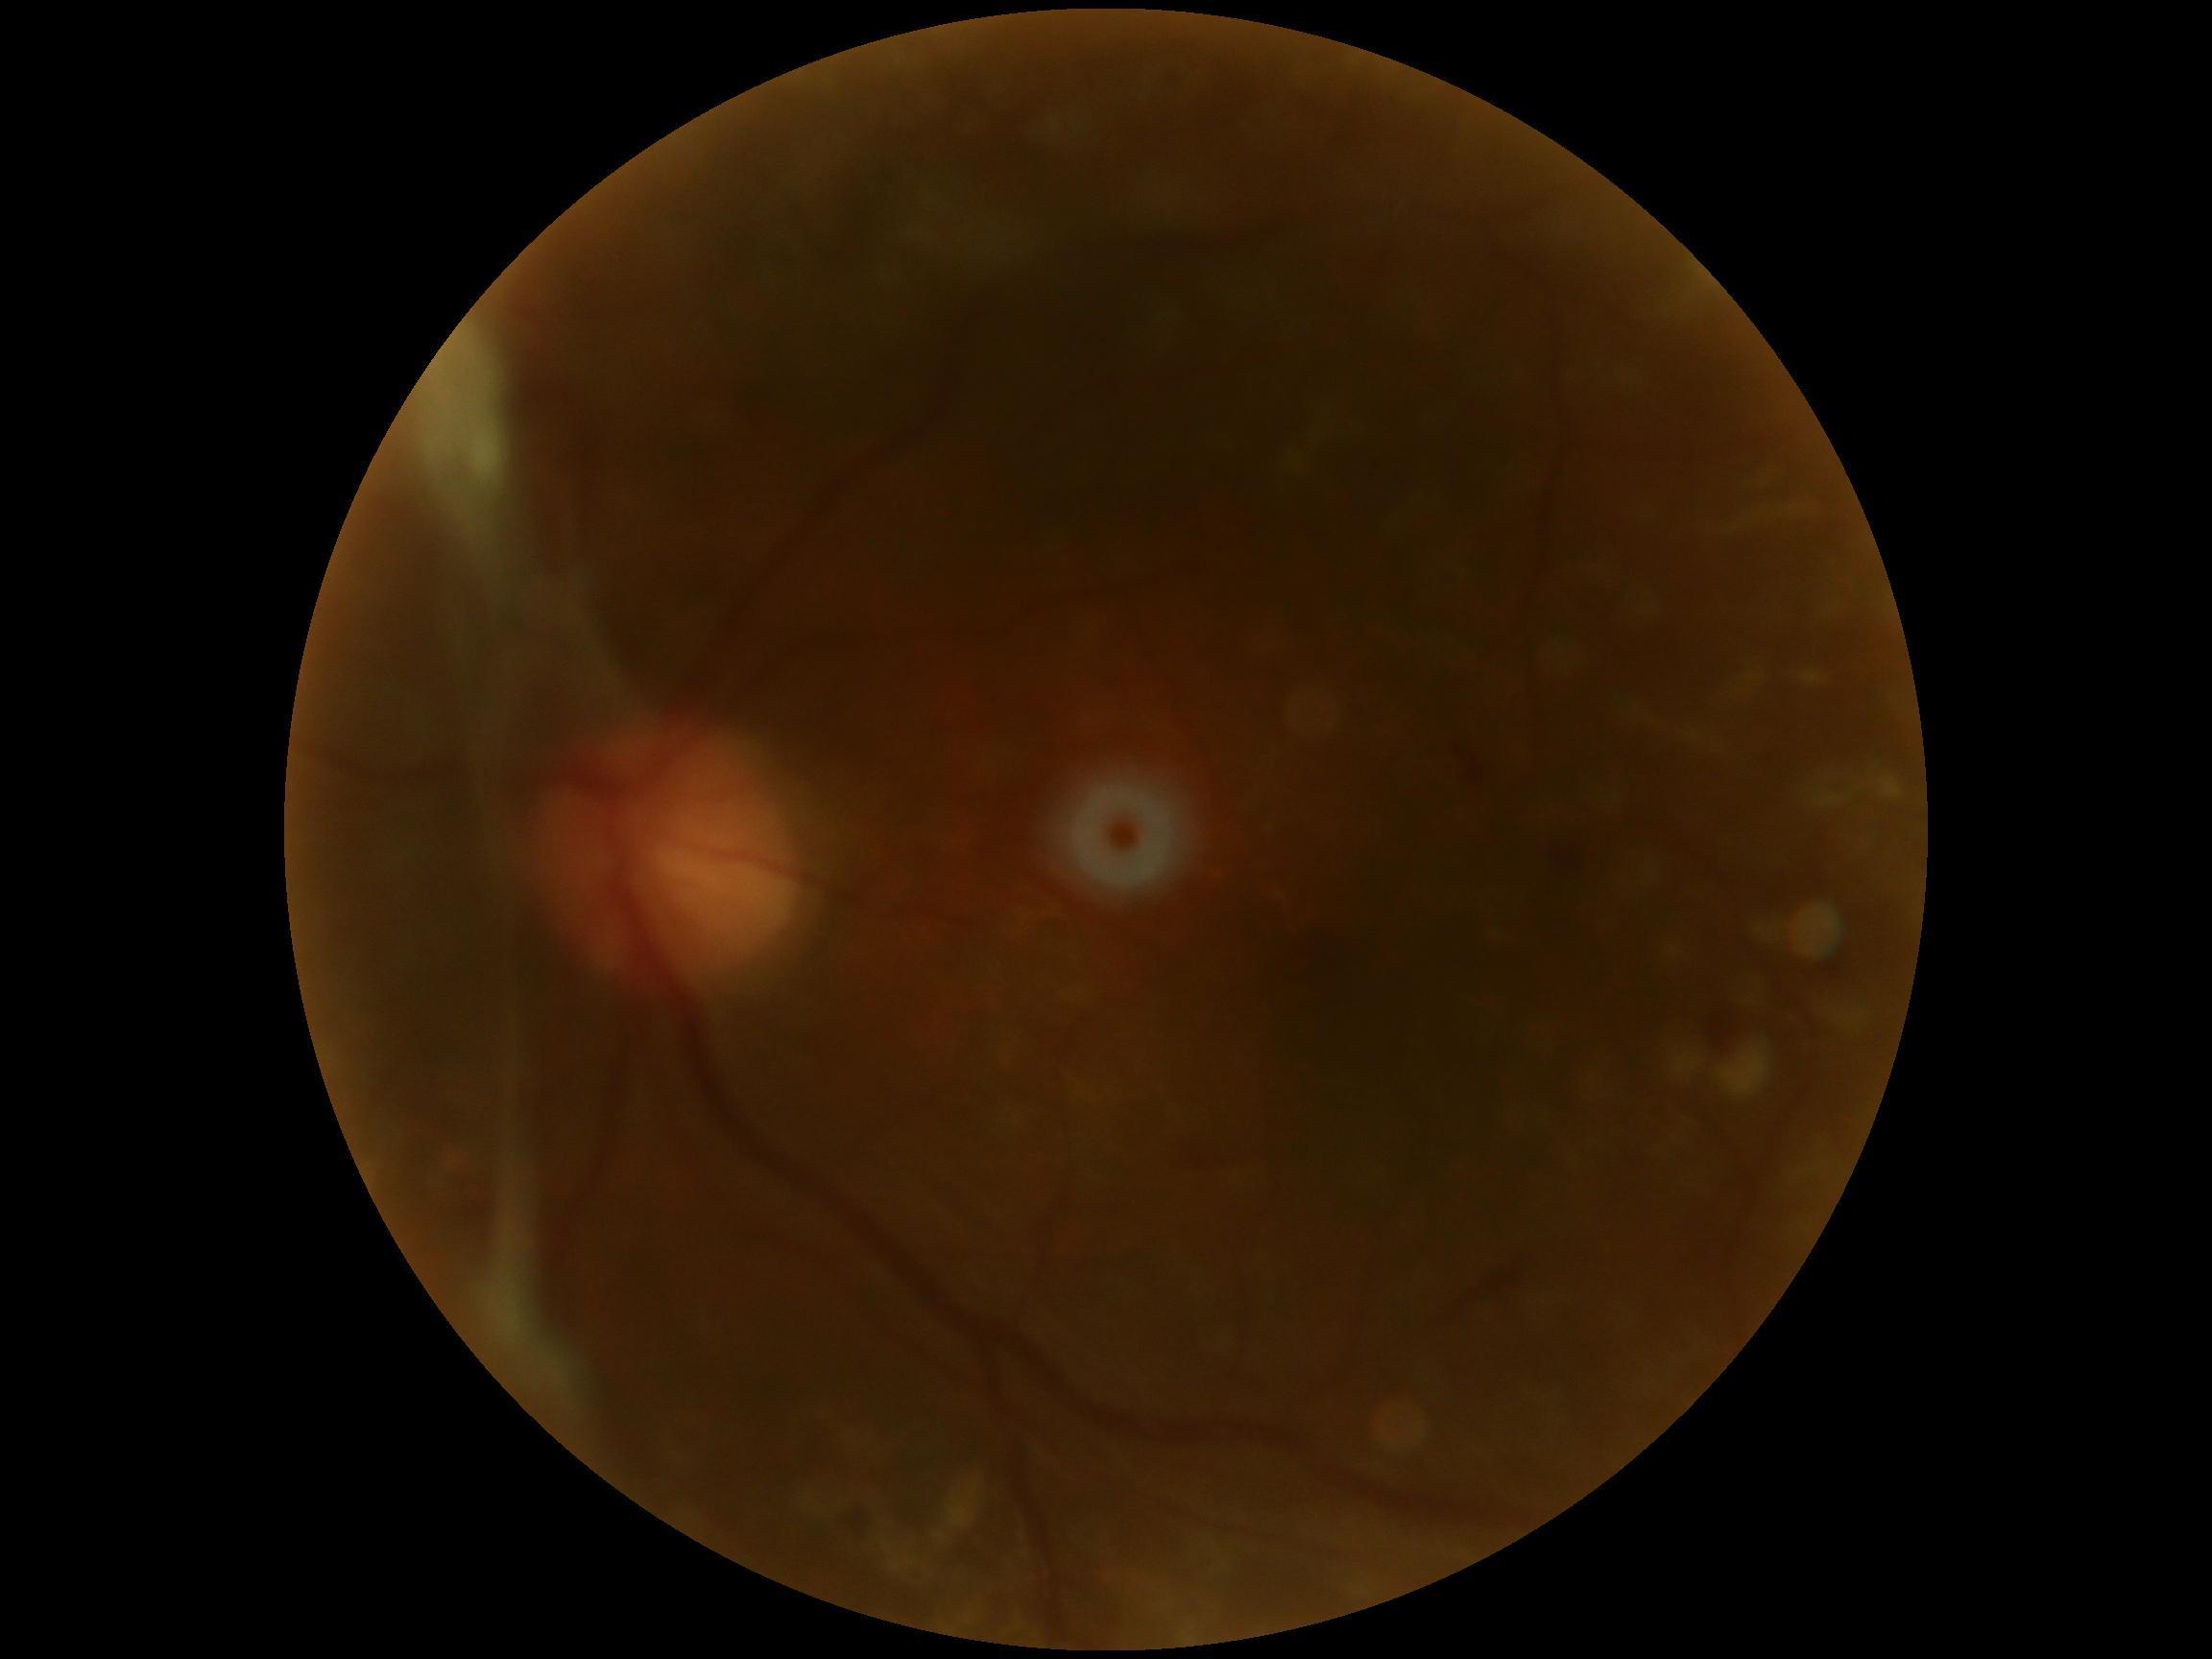

DR class: proliferative diabetic retinopathy, DR: 4.